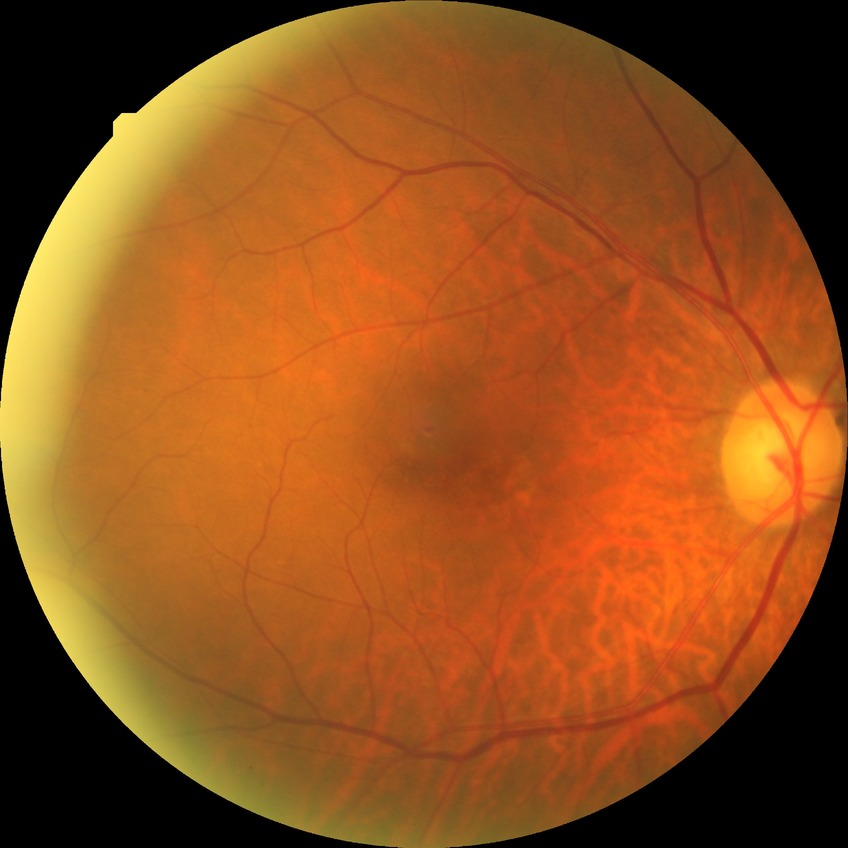 Diabetic retinopathy (DR): simple diabetic retinopathy (SDR).